848x848; retinal fundus photograph: 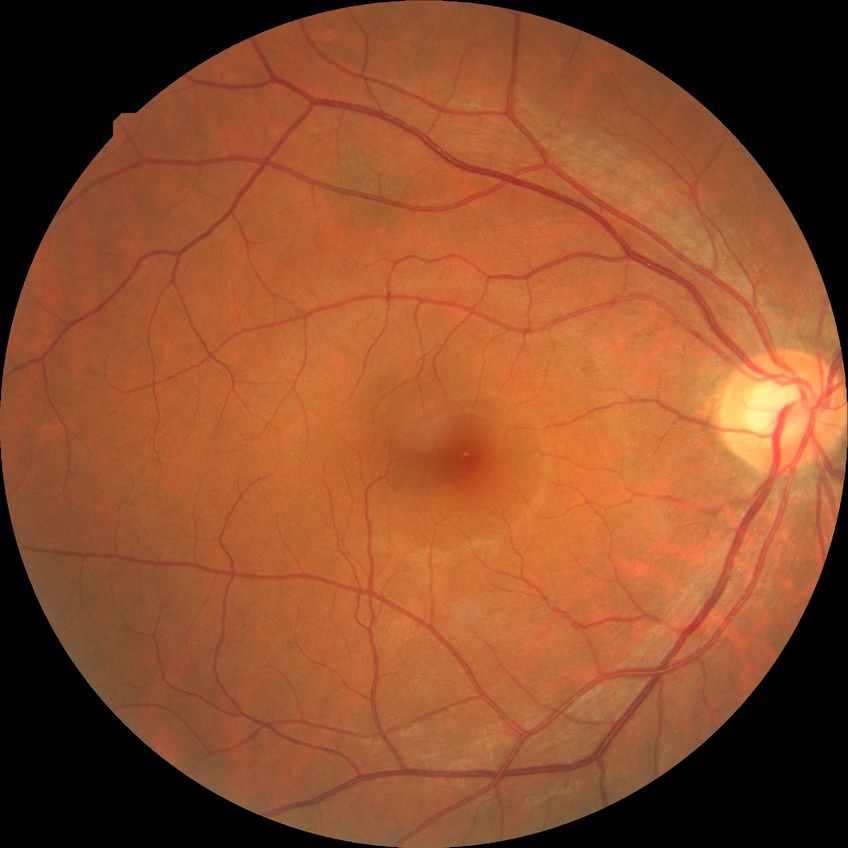
Diabetic retinopathy (DR) is NDR (no diabetic retinopathy).